Wide-field fundus image from infant ROP screening:
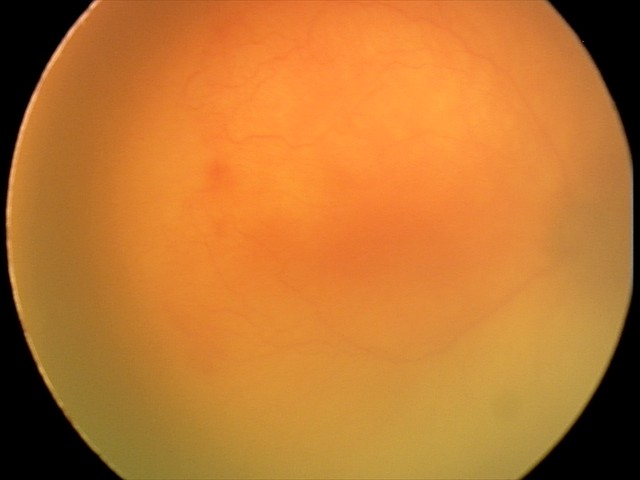
Examination diagnosed as aggressive retinopathy of prematurity. Plus disease was diagnosed.